Fundus photo; 45-degree field of view; image size 2212x1659
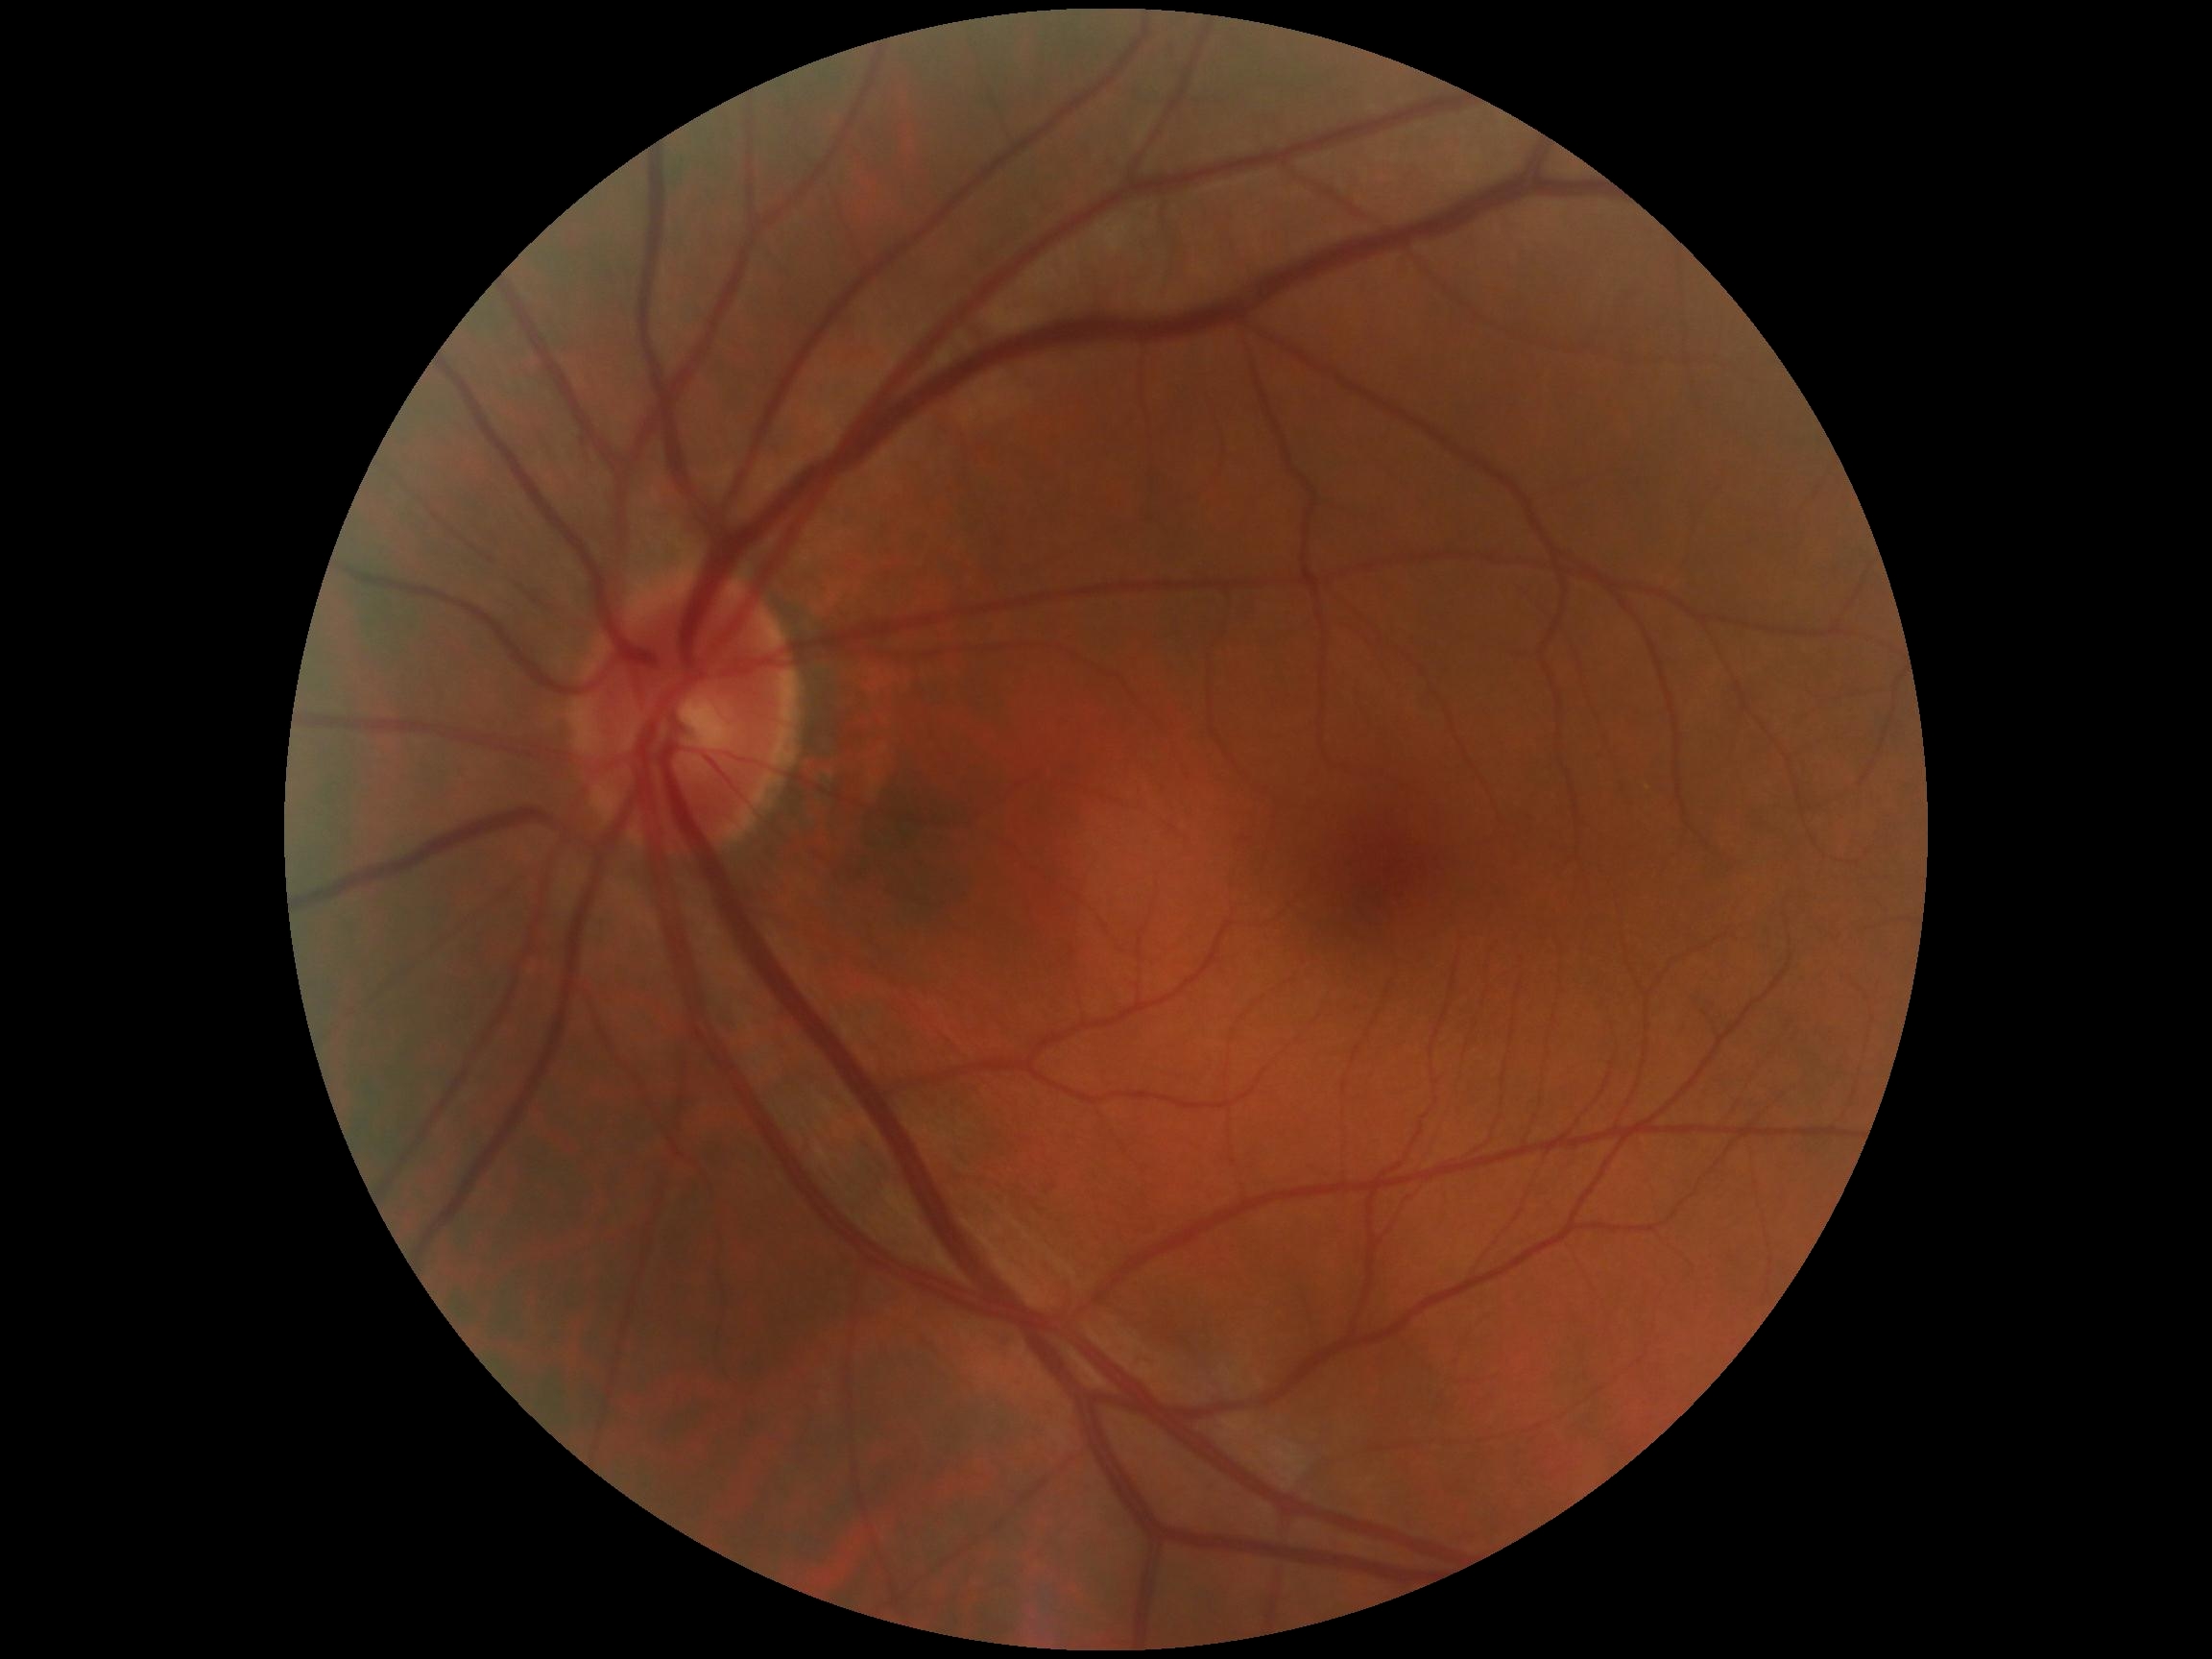

DR grade: 0/4.